Retinal fundus photograph; 2212x1659px; 45-degree field of view
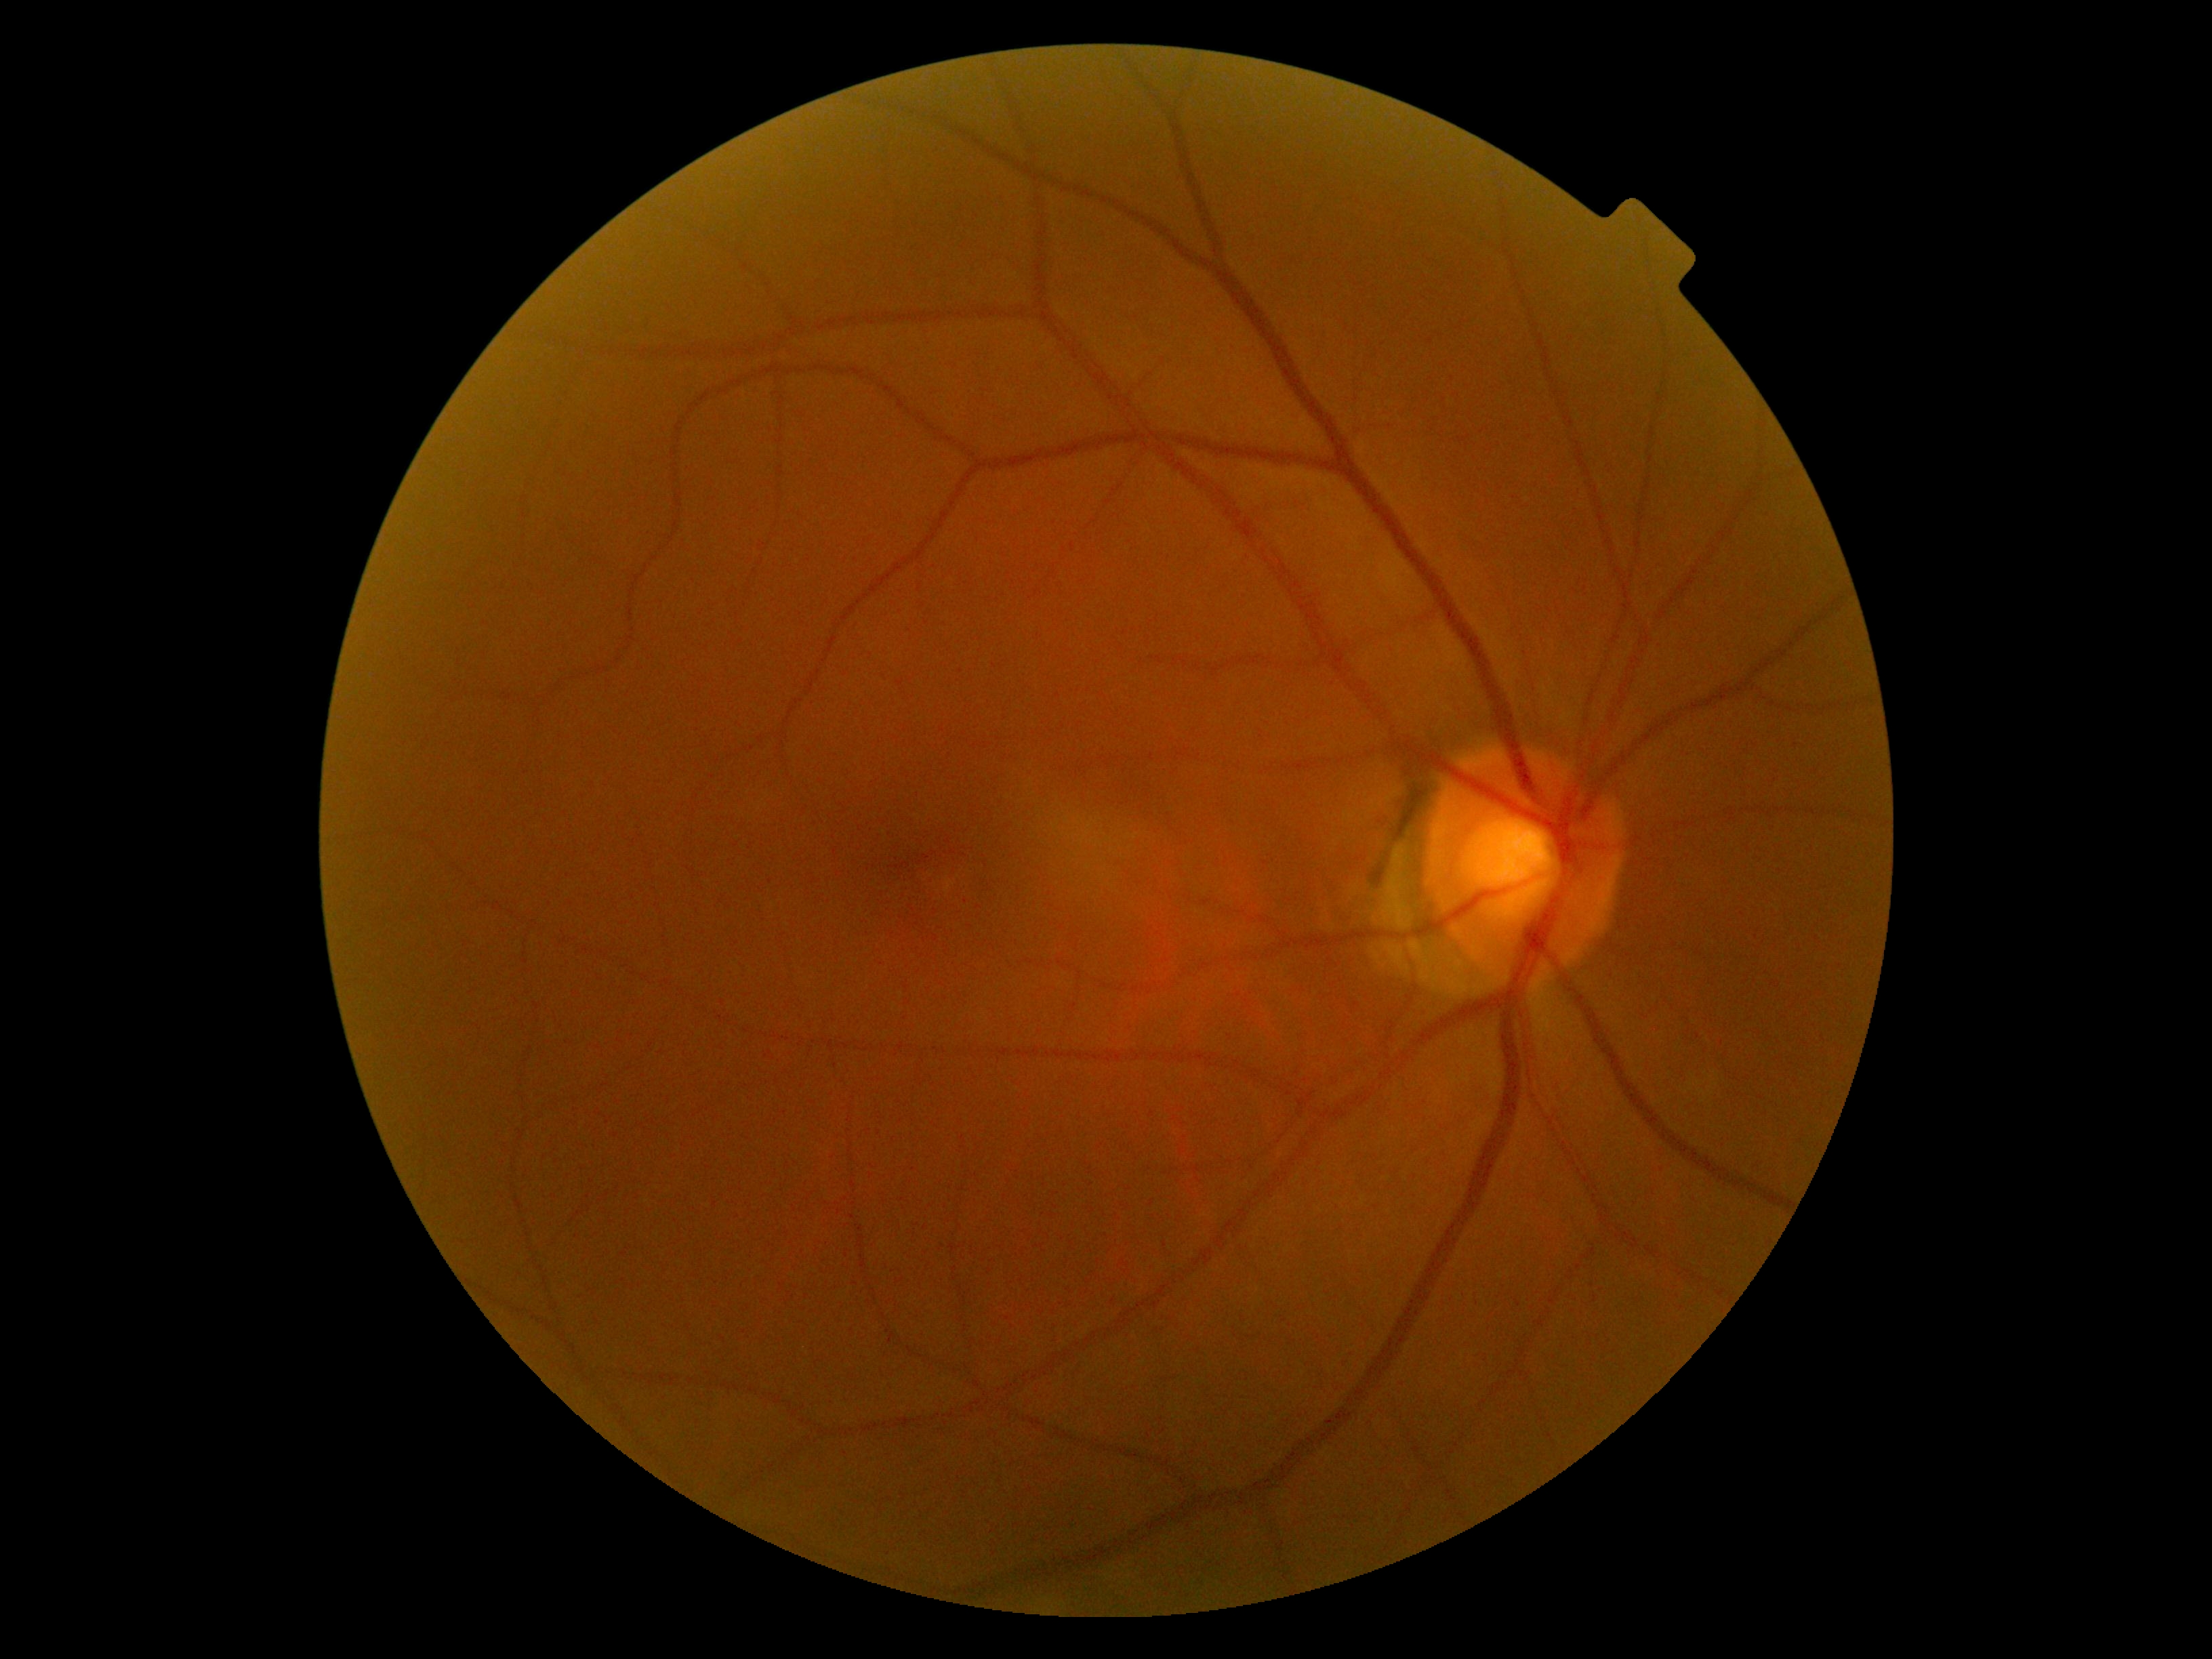 Diabetic retinopathy (DR) is no apparent retinopathy (grade 0).